FOV: 45 degrees:
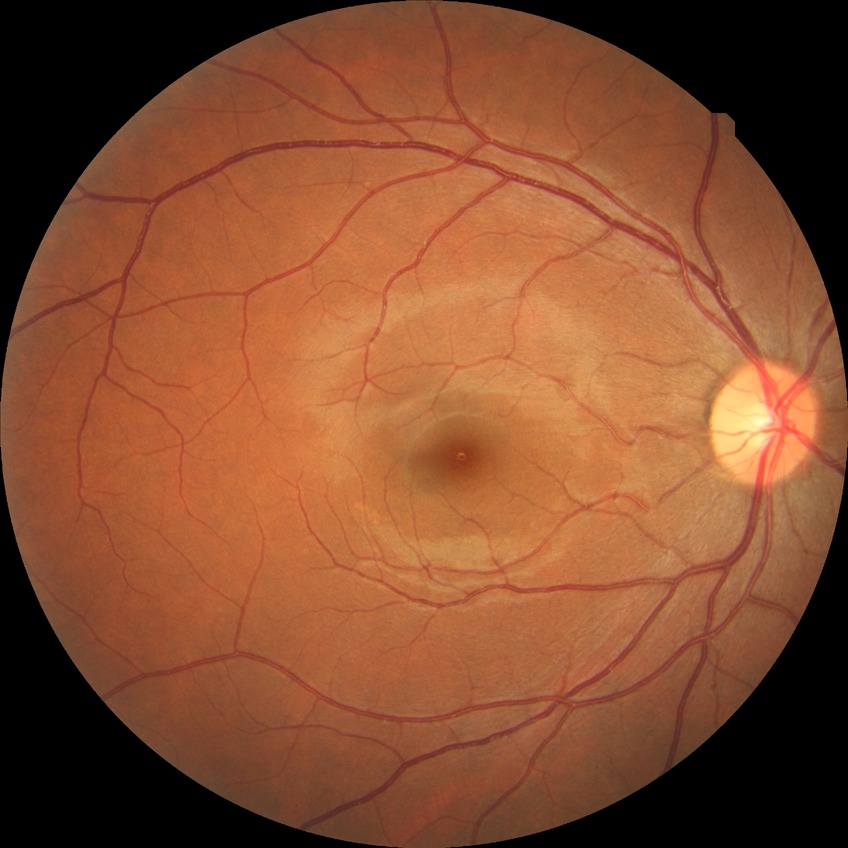 {
  "davis_grade": "NDR (no diabetic retinopathy)"
}